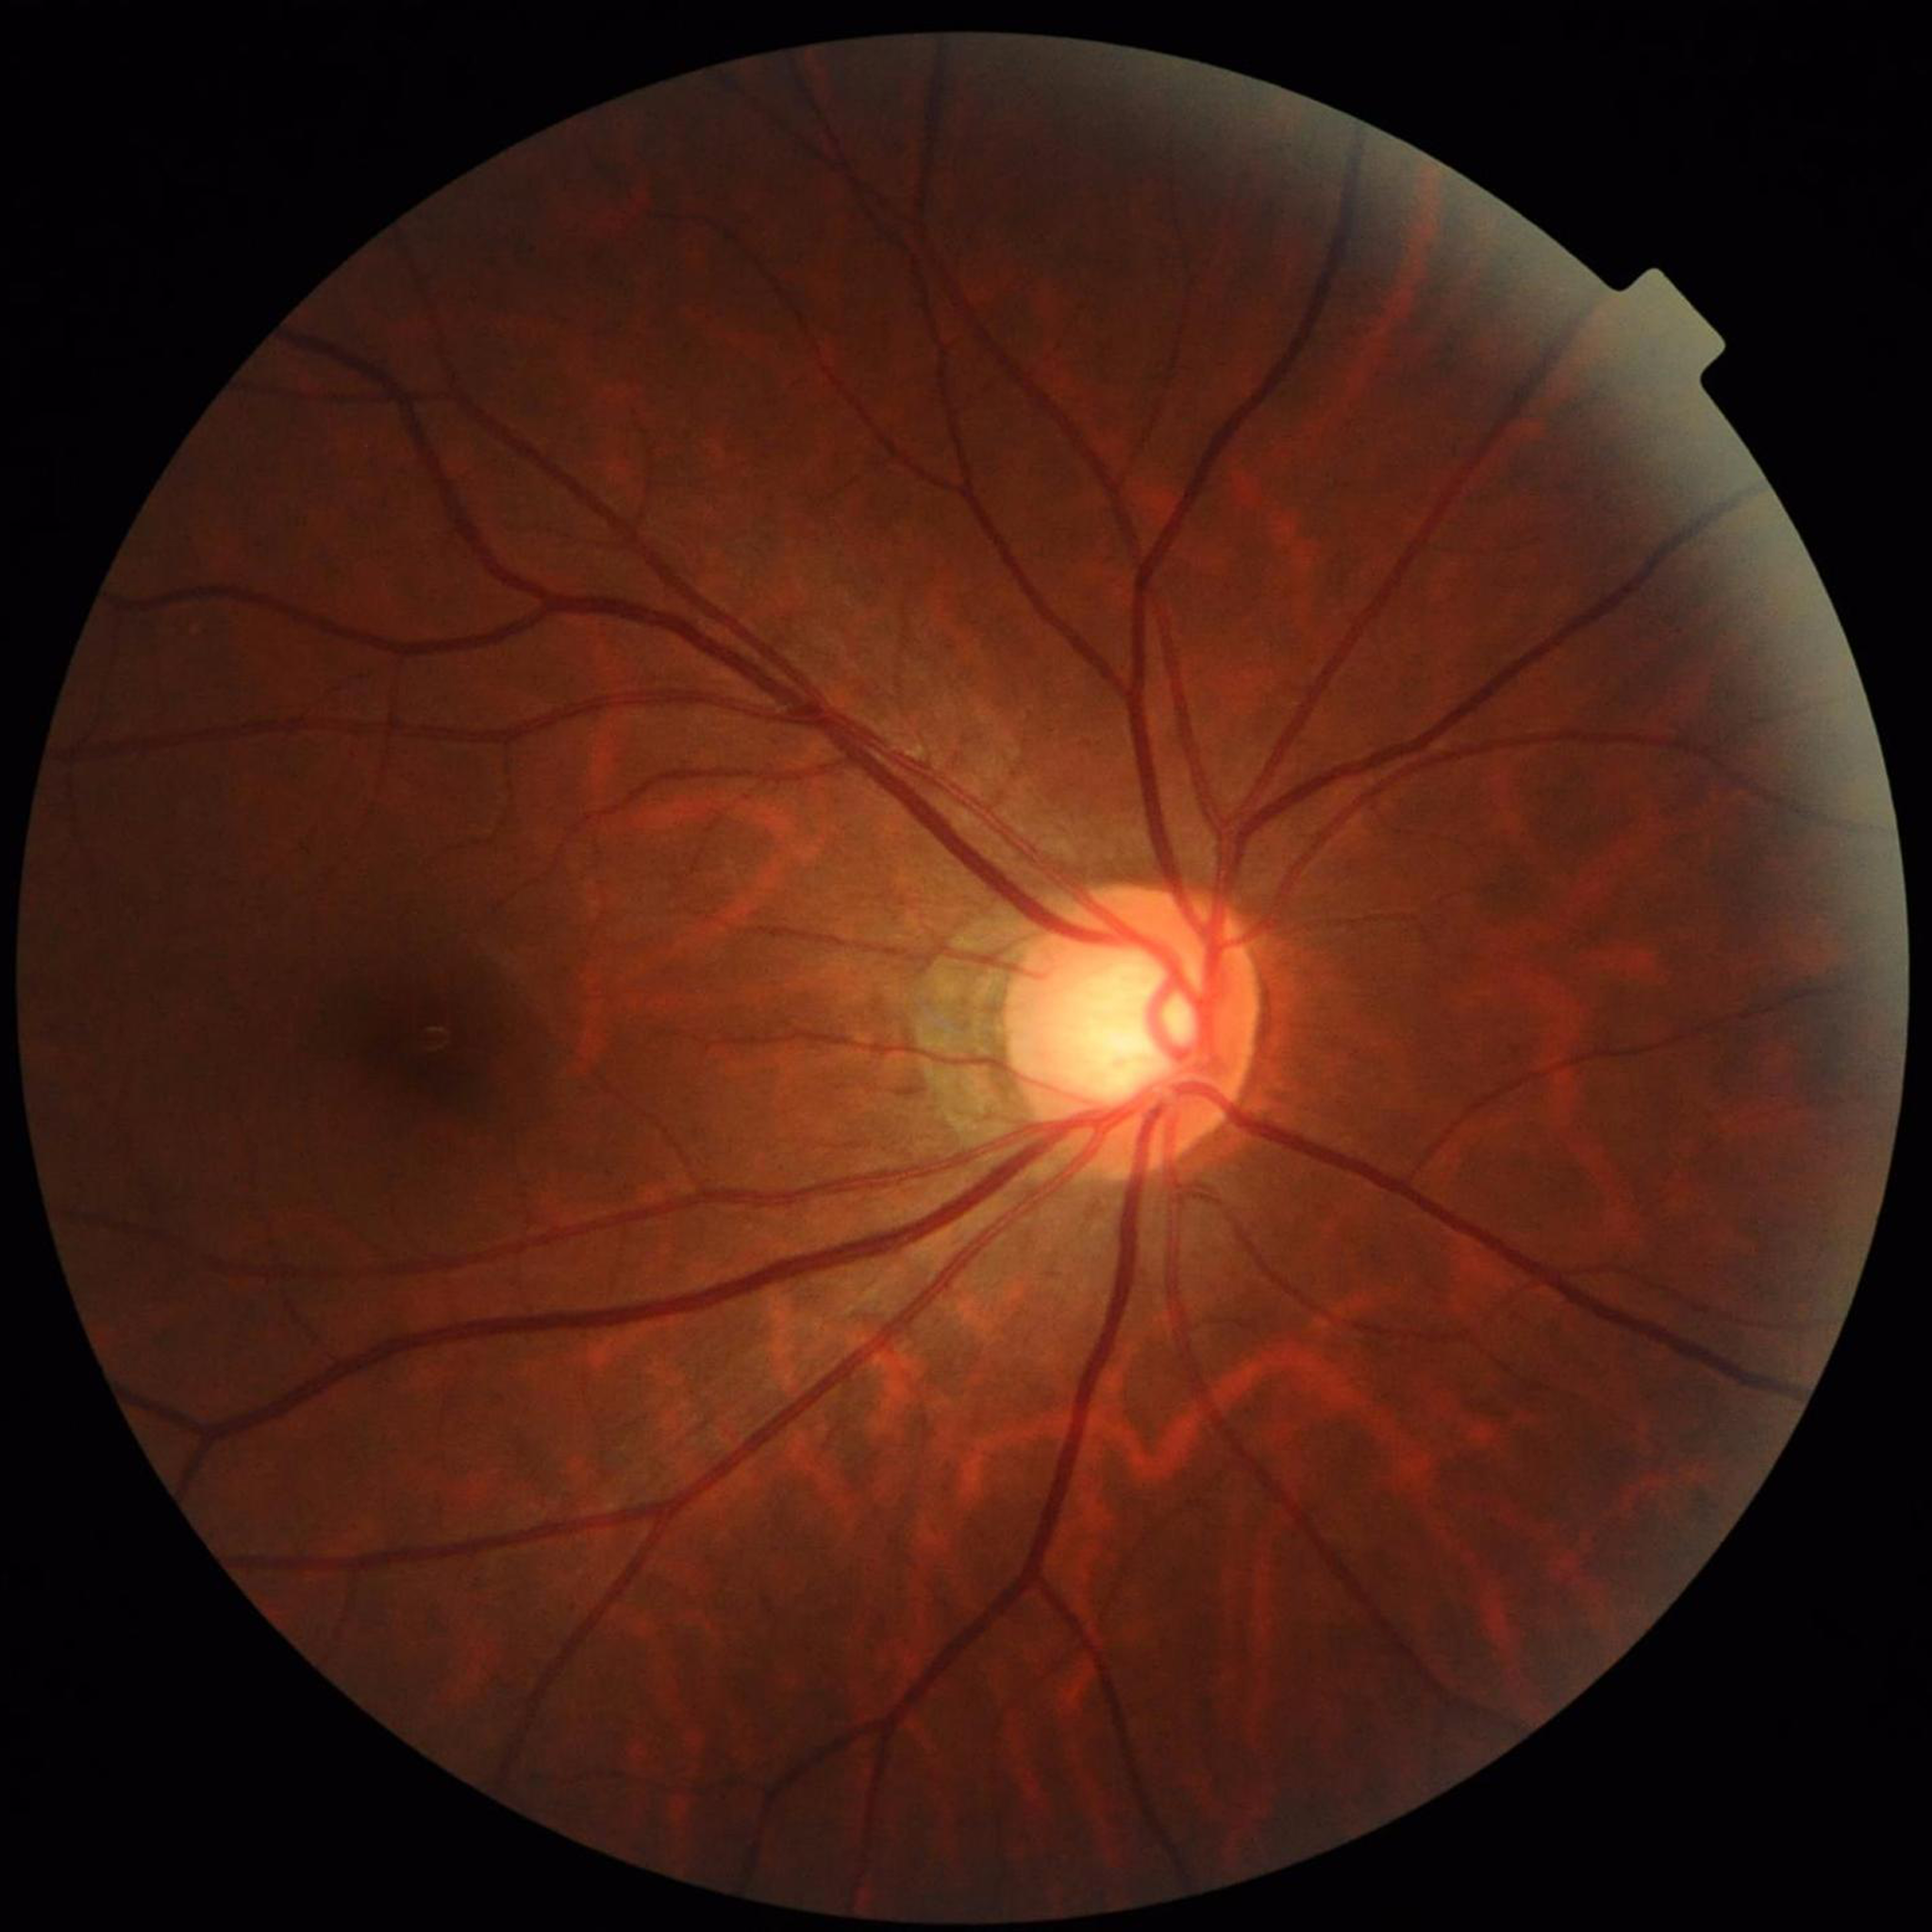 Diagnosed with glaucoma.